Fundus photo
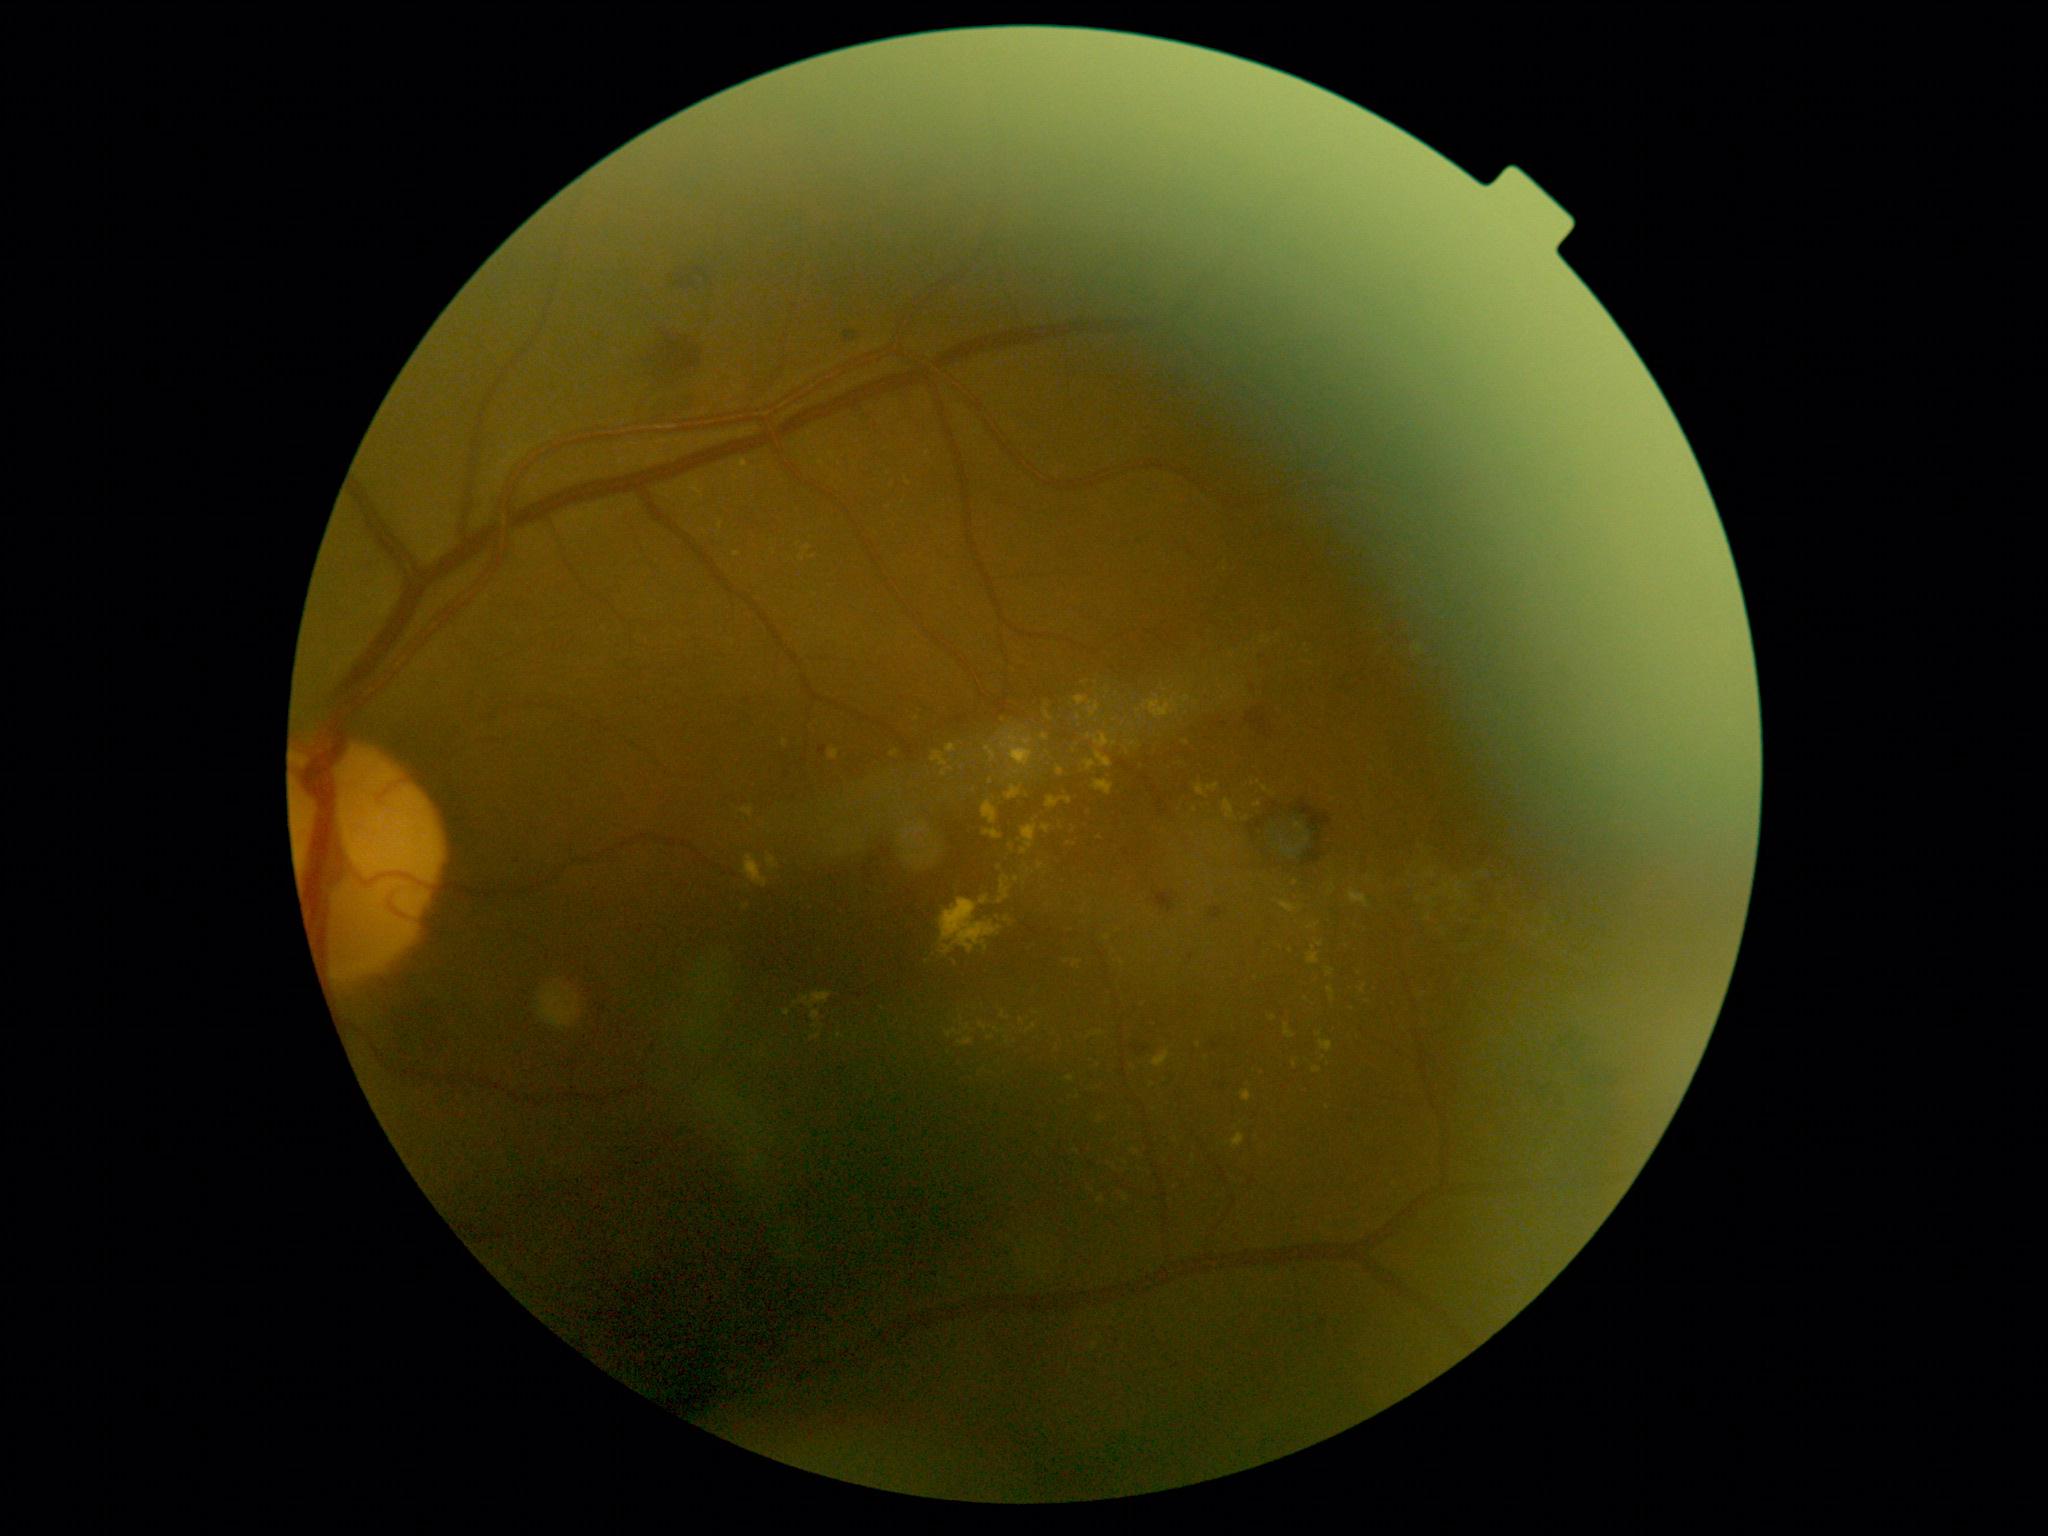
DR is grade 2 (moderate NPDR) — more than just microaneurysms but less than severe NPDR. EXs include lesions at bbox(1093, 781, 1113, 795); bbox(1002, 732, 1034, 767); bbox(1042, 824, 1051, 835); bbox(963, 1024, 971, 1032); bbox(1284, 1024, 1296, 1040); bbox(1436, 890, 1444, 895); bbox(811, 1034, 822, 1042); bbox(1087, 733, 1118, 749); bbox(995, 1029, 1005, 1034); bbox(1084, 761, 1096, 772). EXs (small, approximate centers) near [x=917, y=719]; [x=737, y=555]; [x=747, y=907]; [x=1067, y=962]; [x=1284, y=850]; [x=840, y=852]; [x=1195, y=811]; [x=1165, y=691].